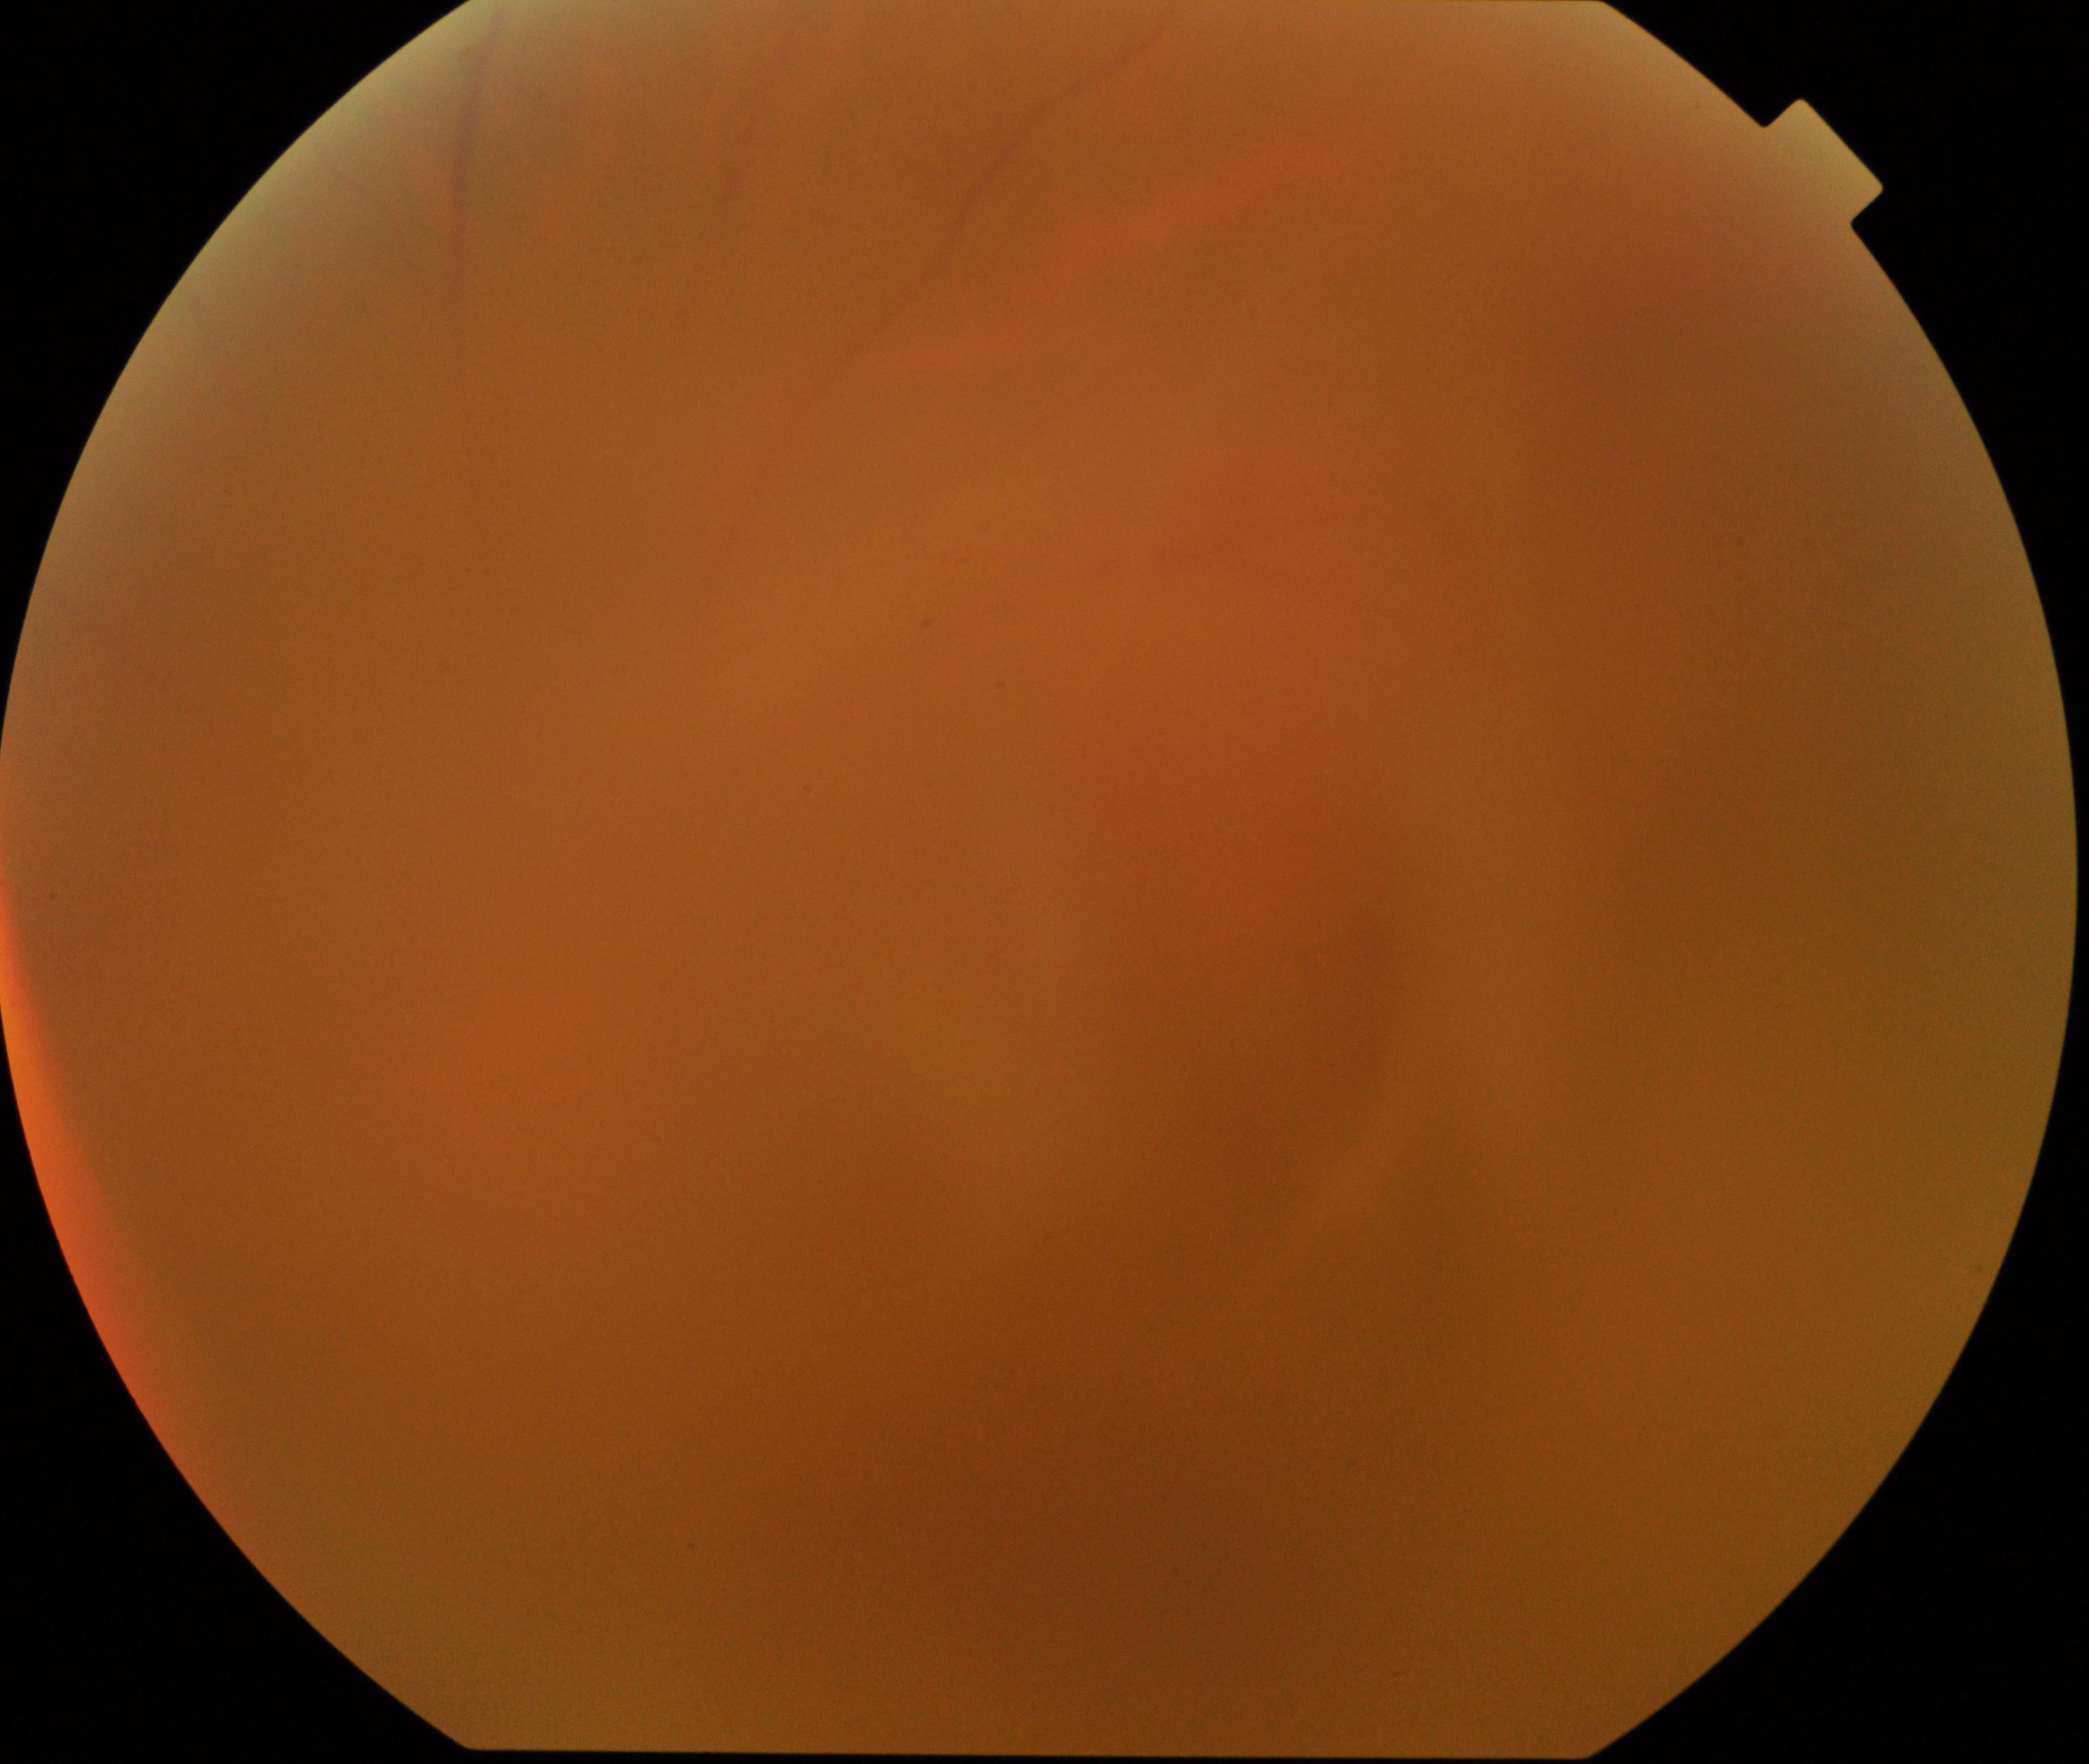
Image is blurred; retinal landmarks are largely obscured. Proliferative diabetic retinopathy not identified in the visible portion.